NIDEK AFC-230; image size 848x848; nonmydriatic fundus photograph
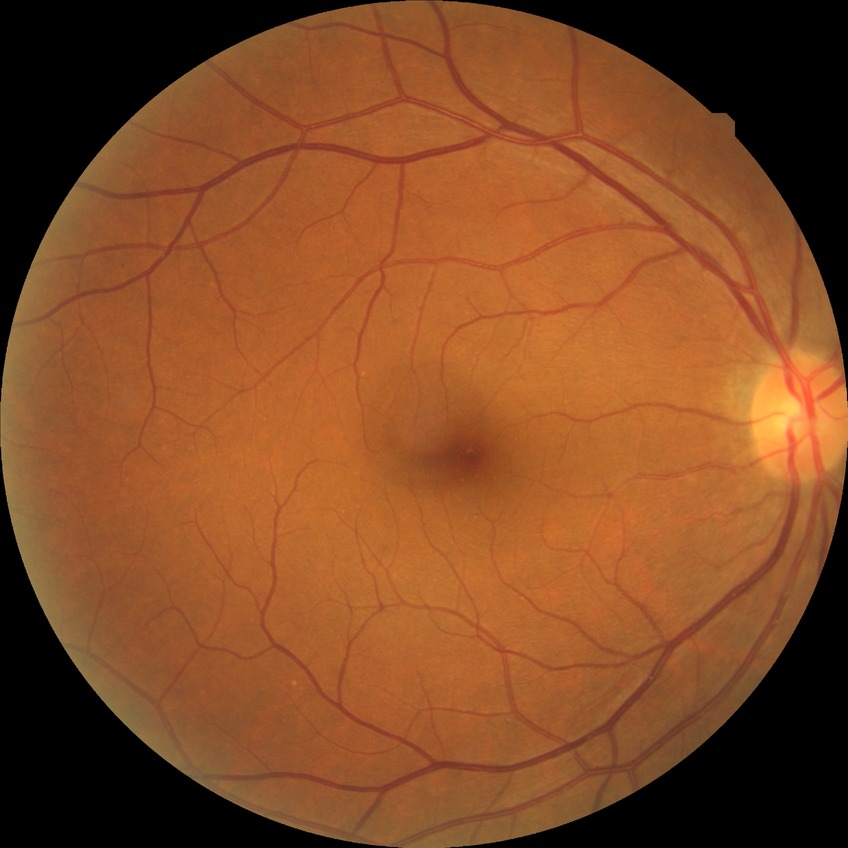

{
  "davis_grade": "NDR"
}